Posterior pole color fundus photograph. FOV: 45 degrees.
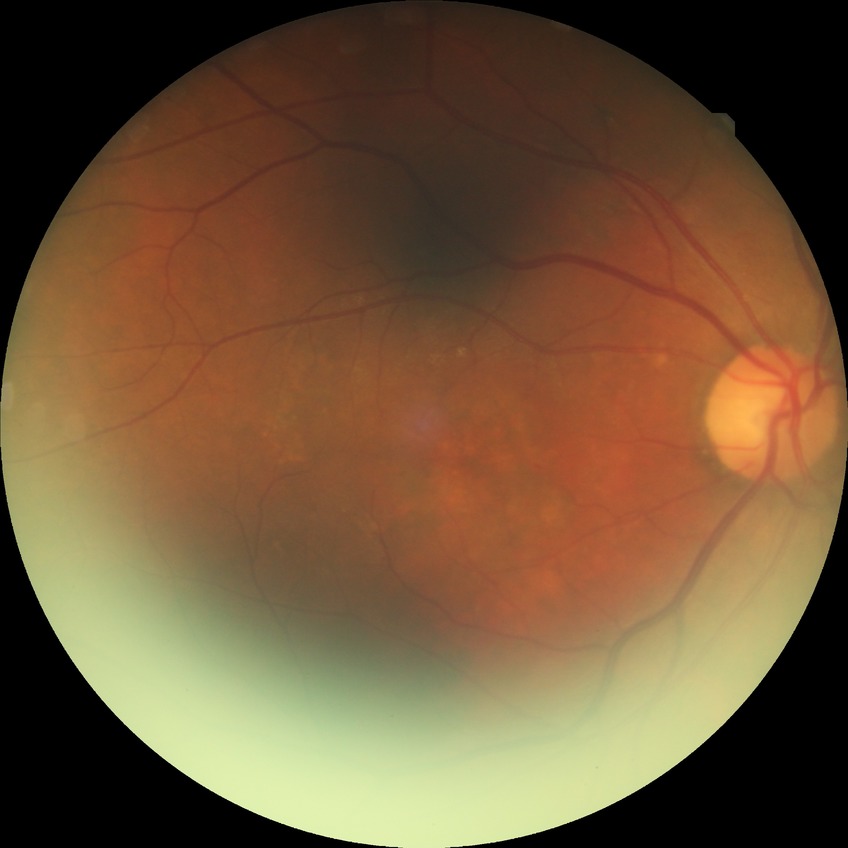 Retinopathy grade is no diabetic retinopathy.